Pediatric wide-field fundus photograph · 1240 x 1240 pixels · camera: Phoenix ICON (100° FOV): 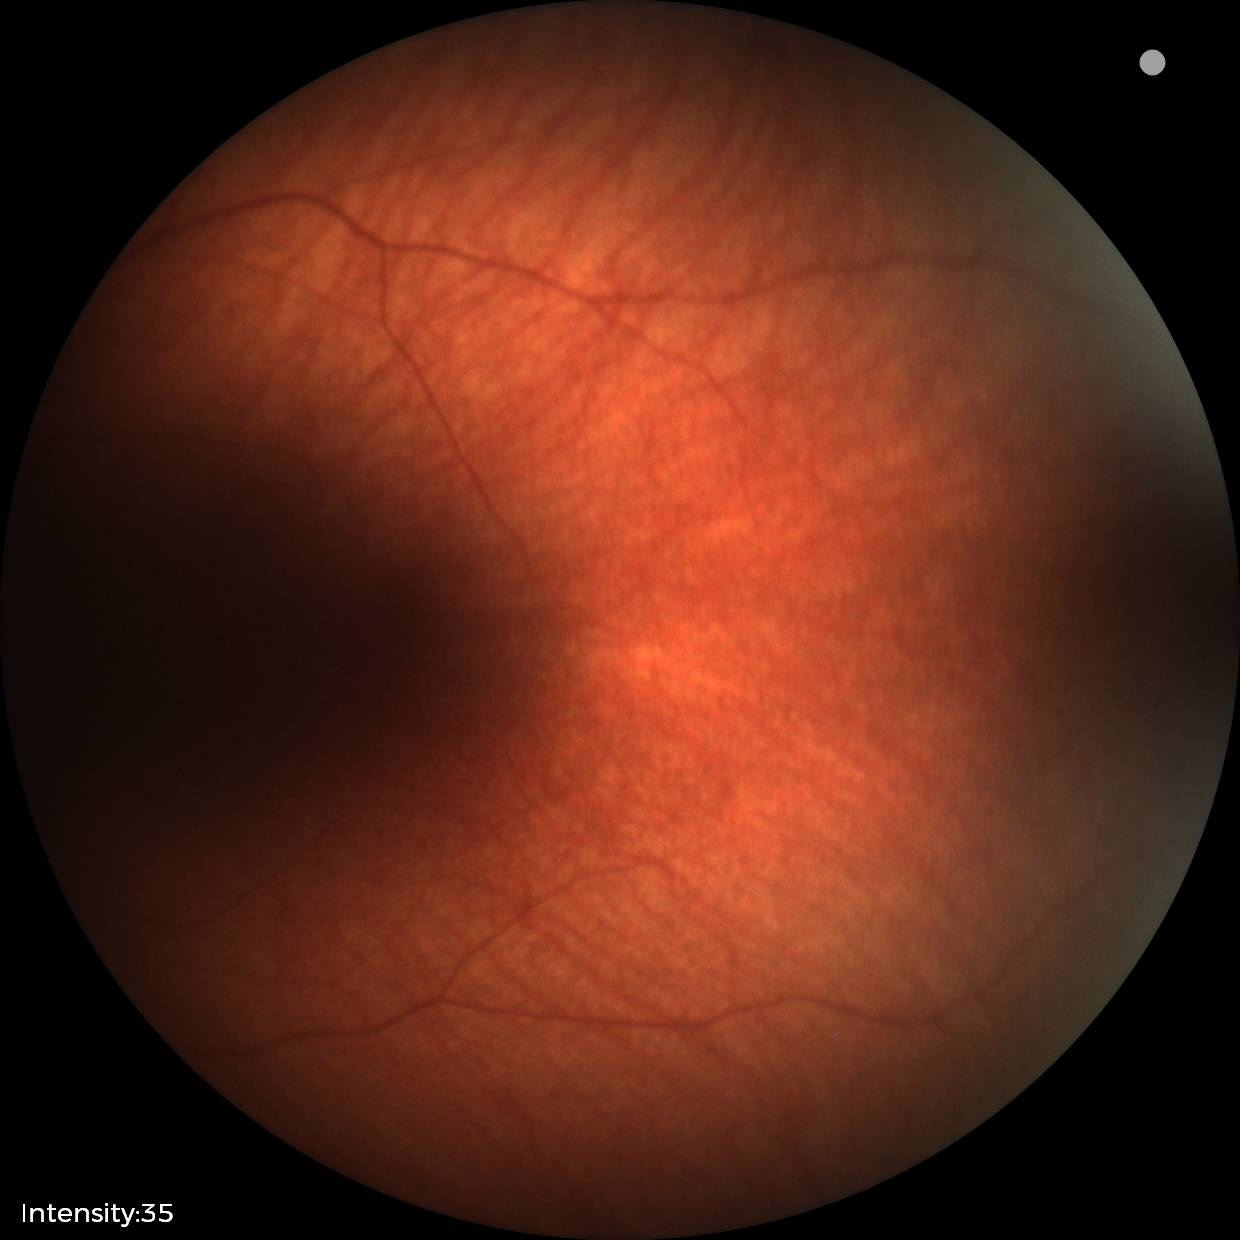
Q: What is the diagnosis from this examination?
A: physiological appearance with no retinal pathology